Color fundus photograph · image size 2352x1568
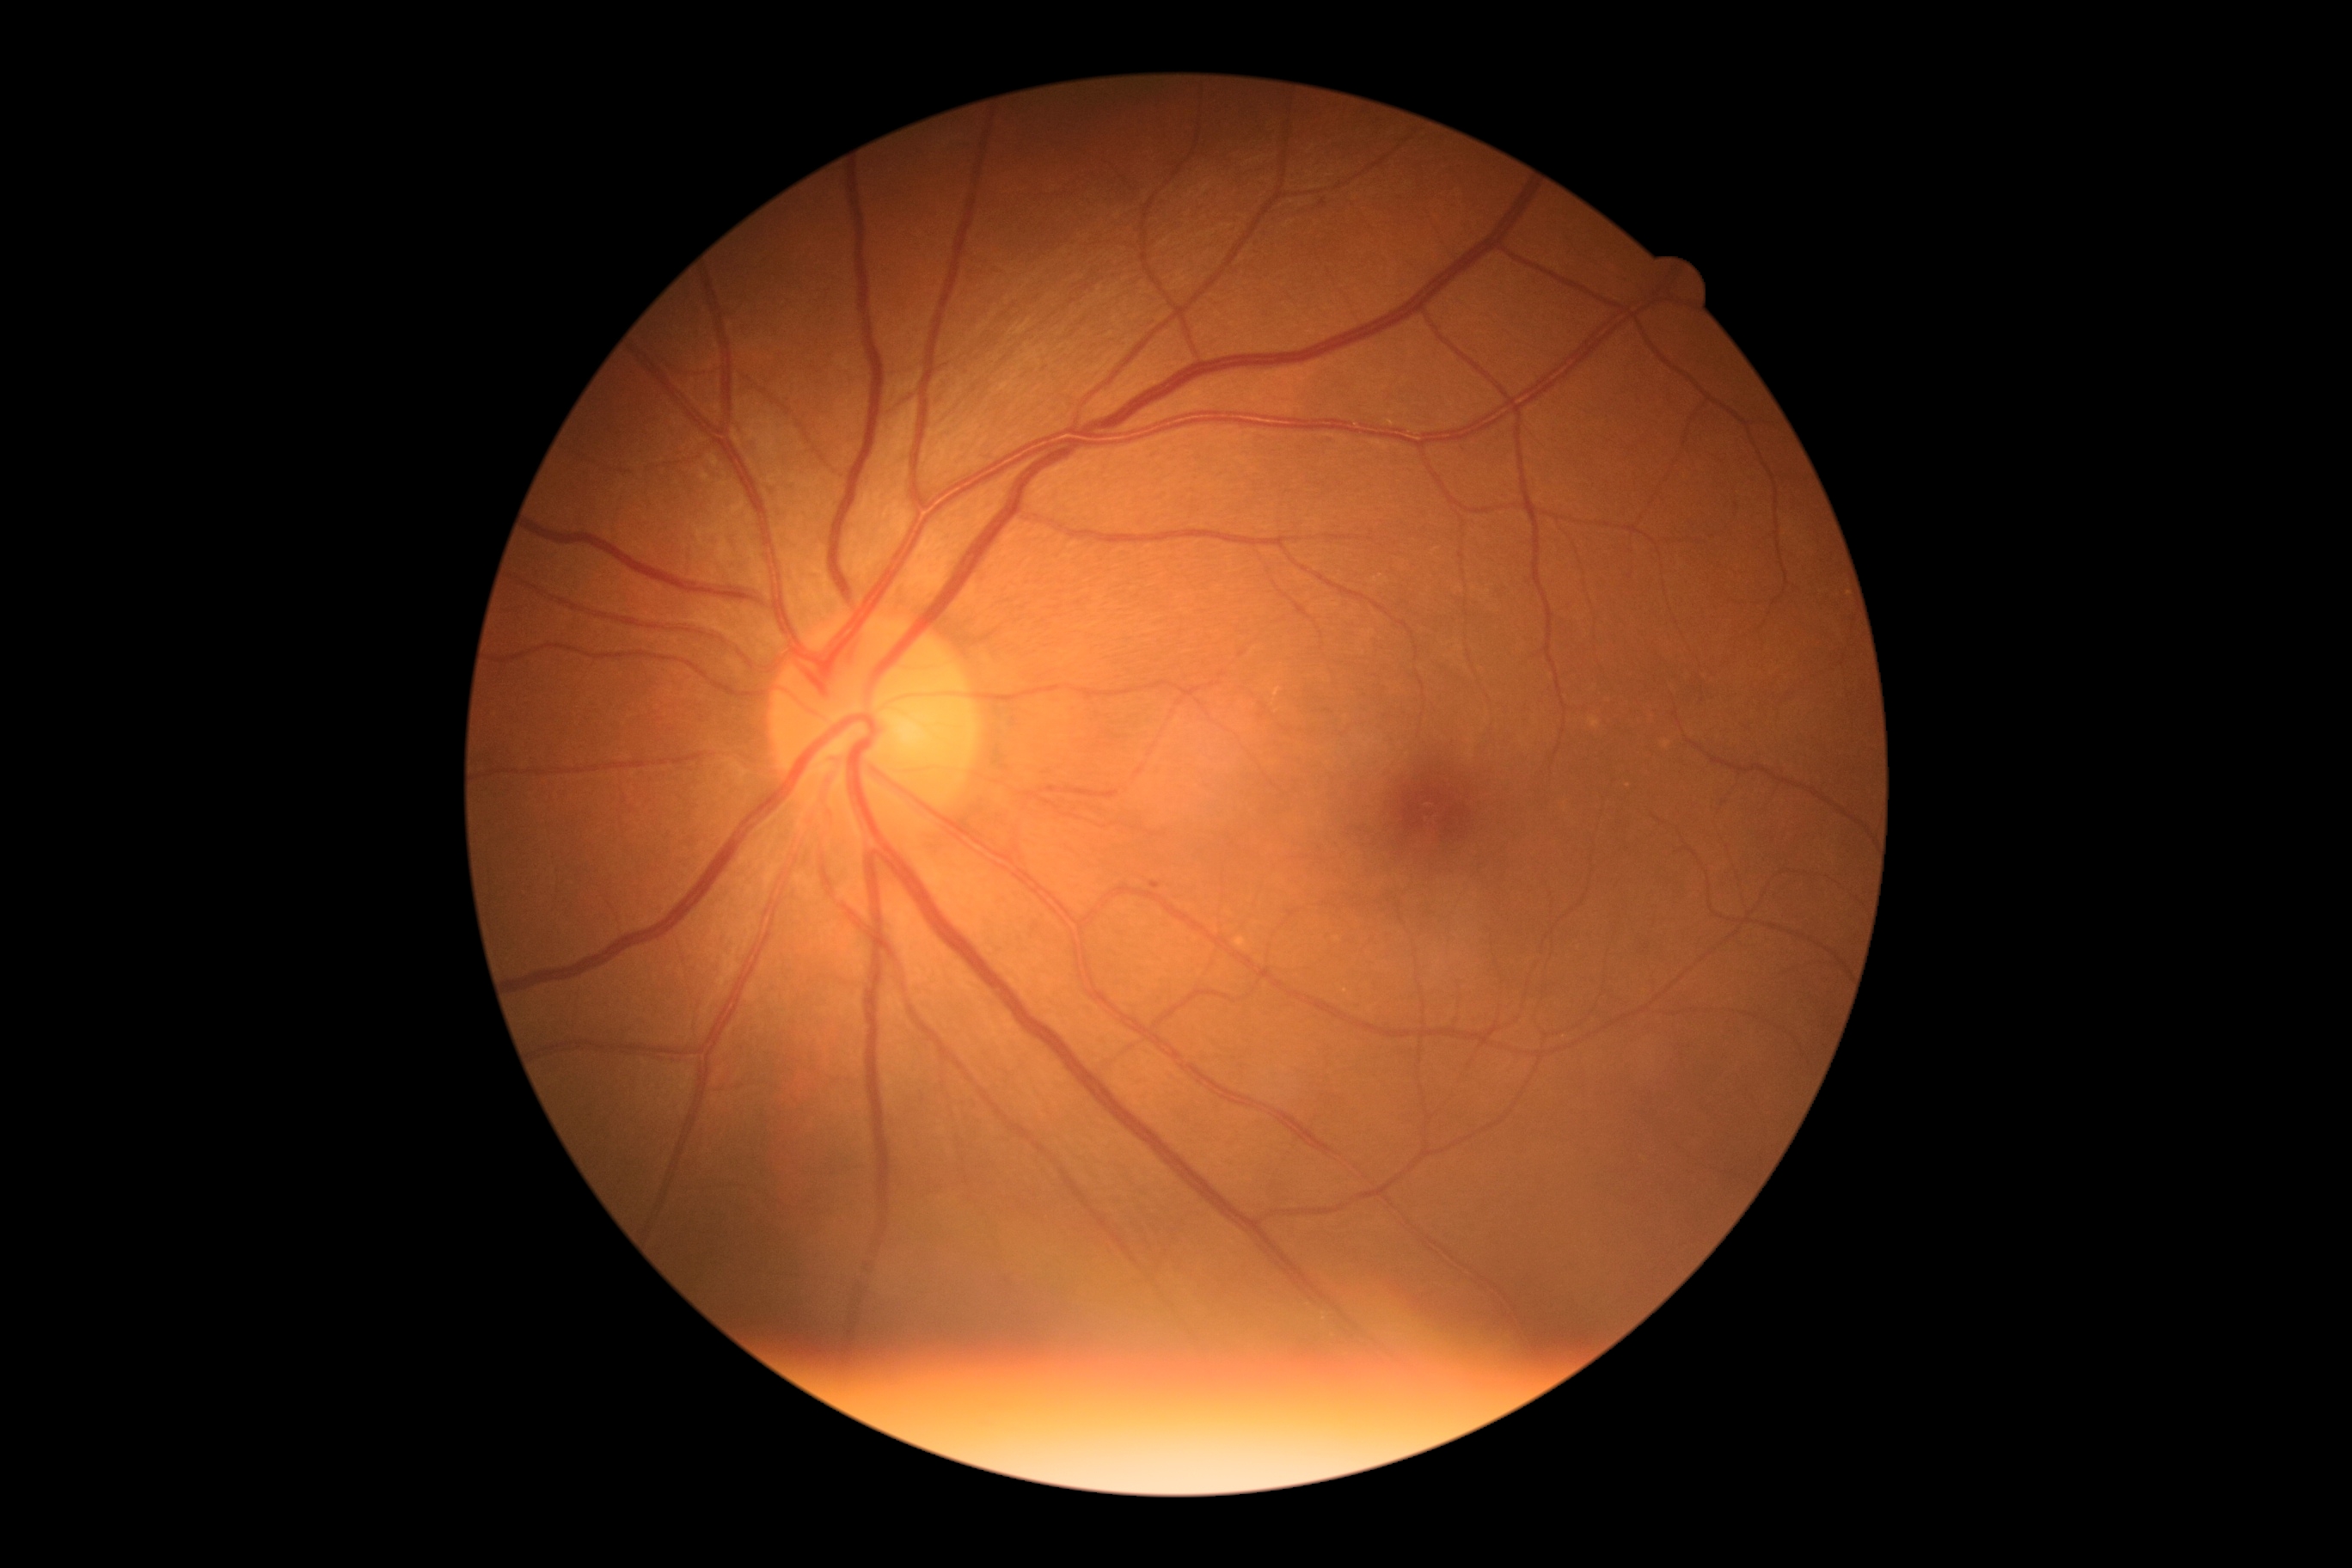 DR: grade 1 (mild NPDR)